Infant wide-field fundus photograph: 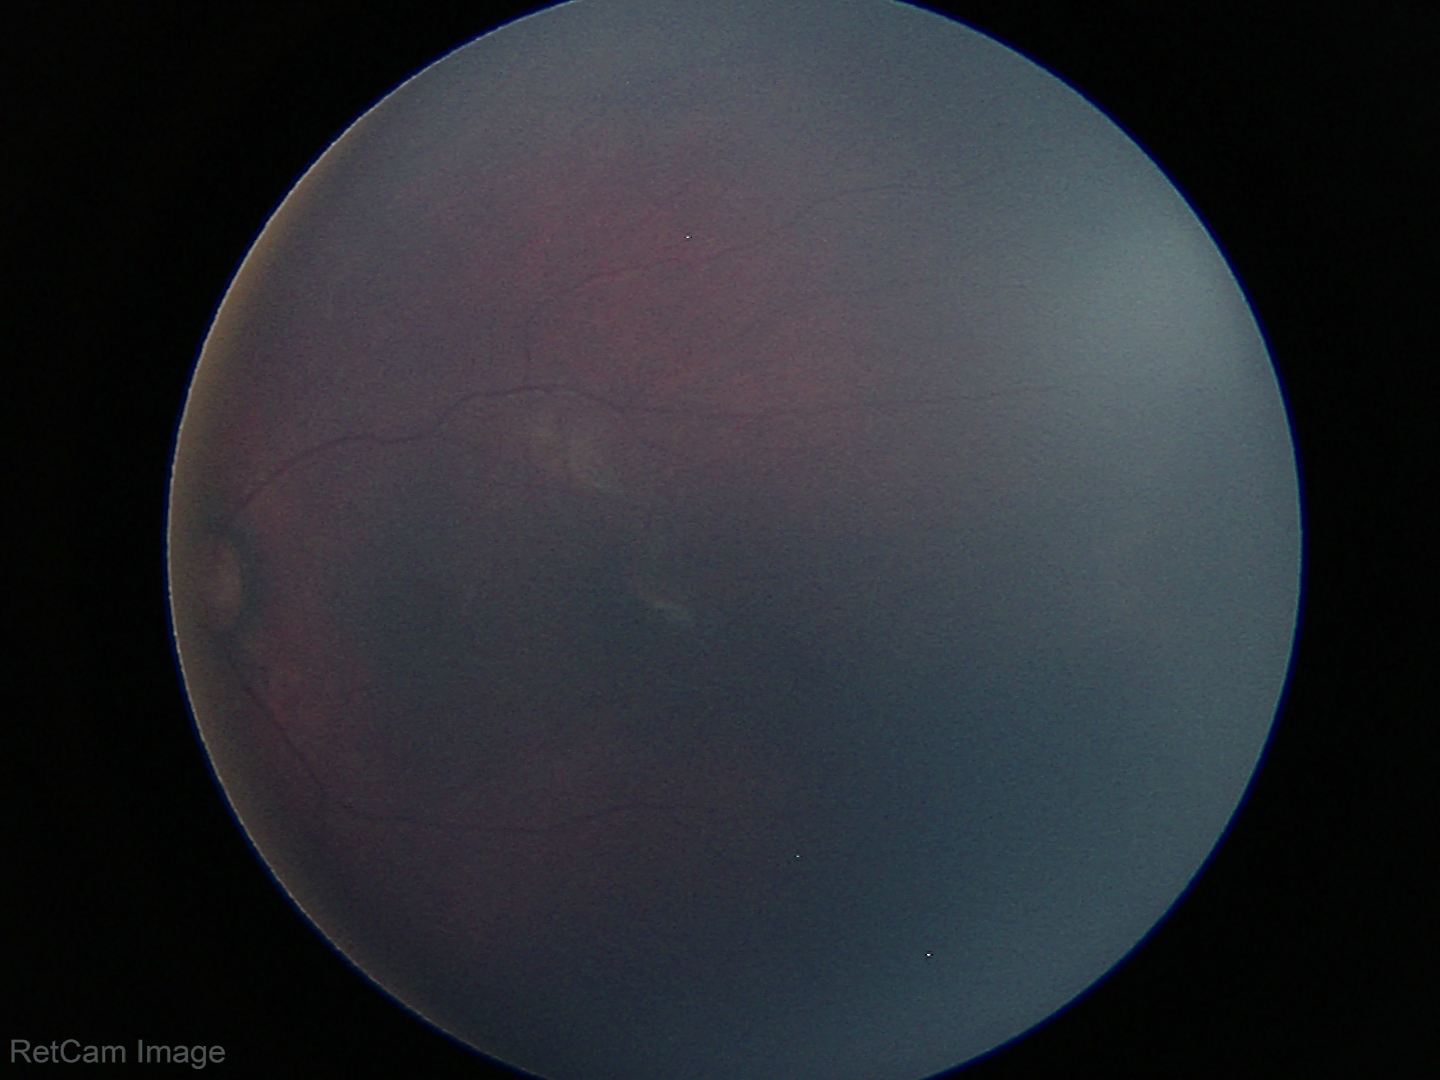 Impression: normal fundus examination.